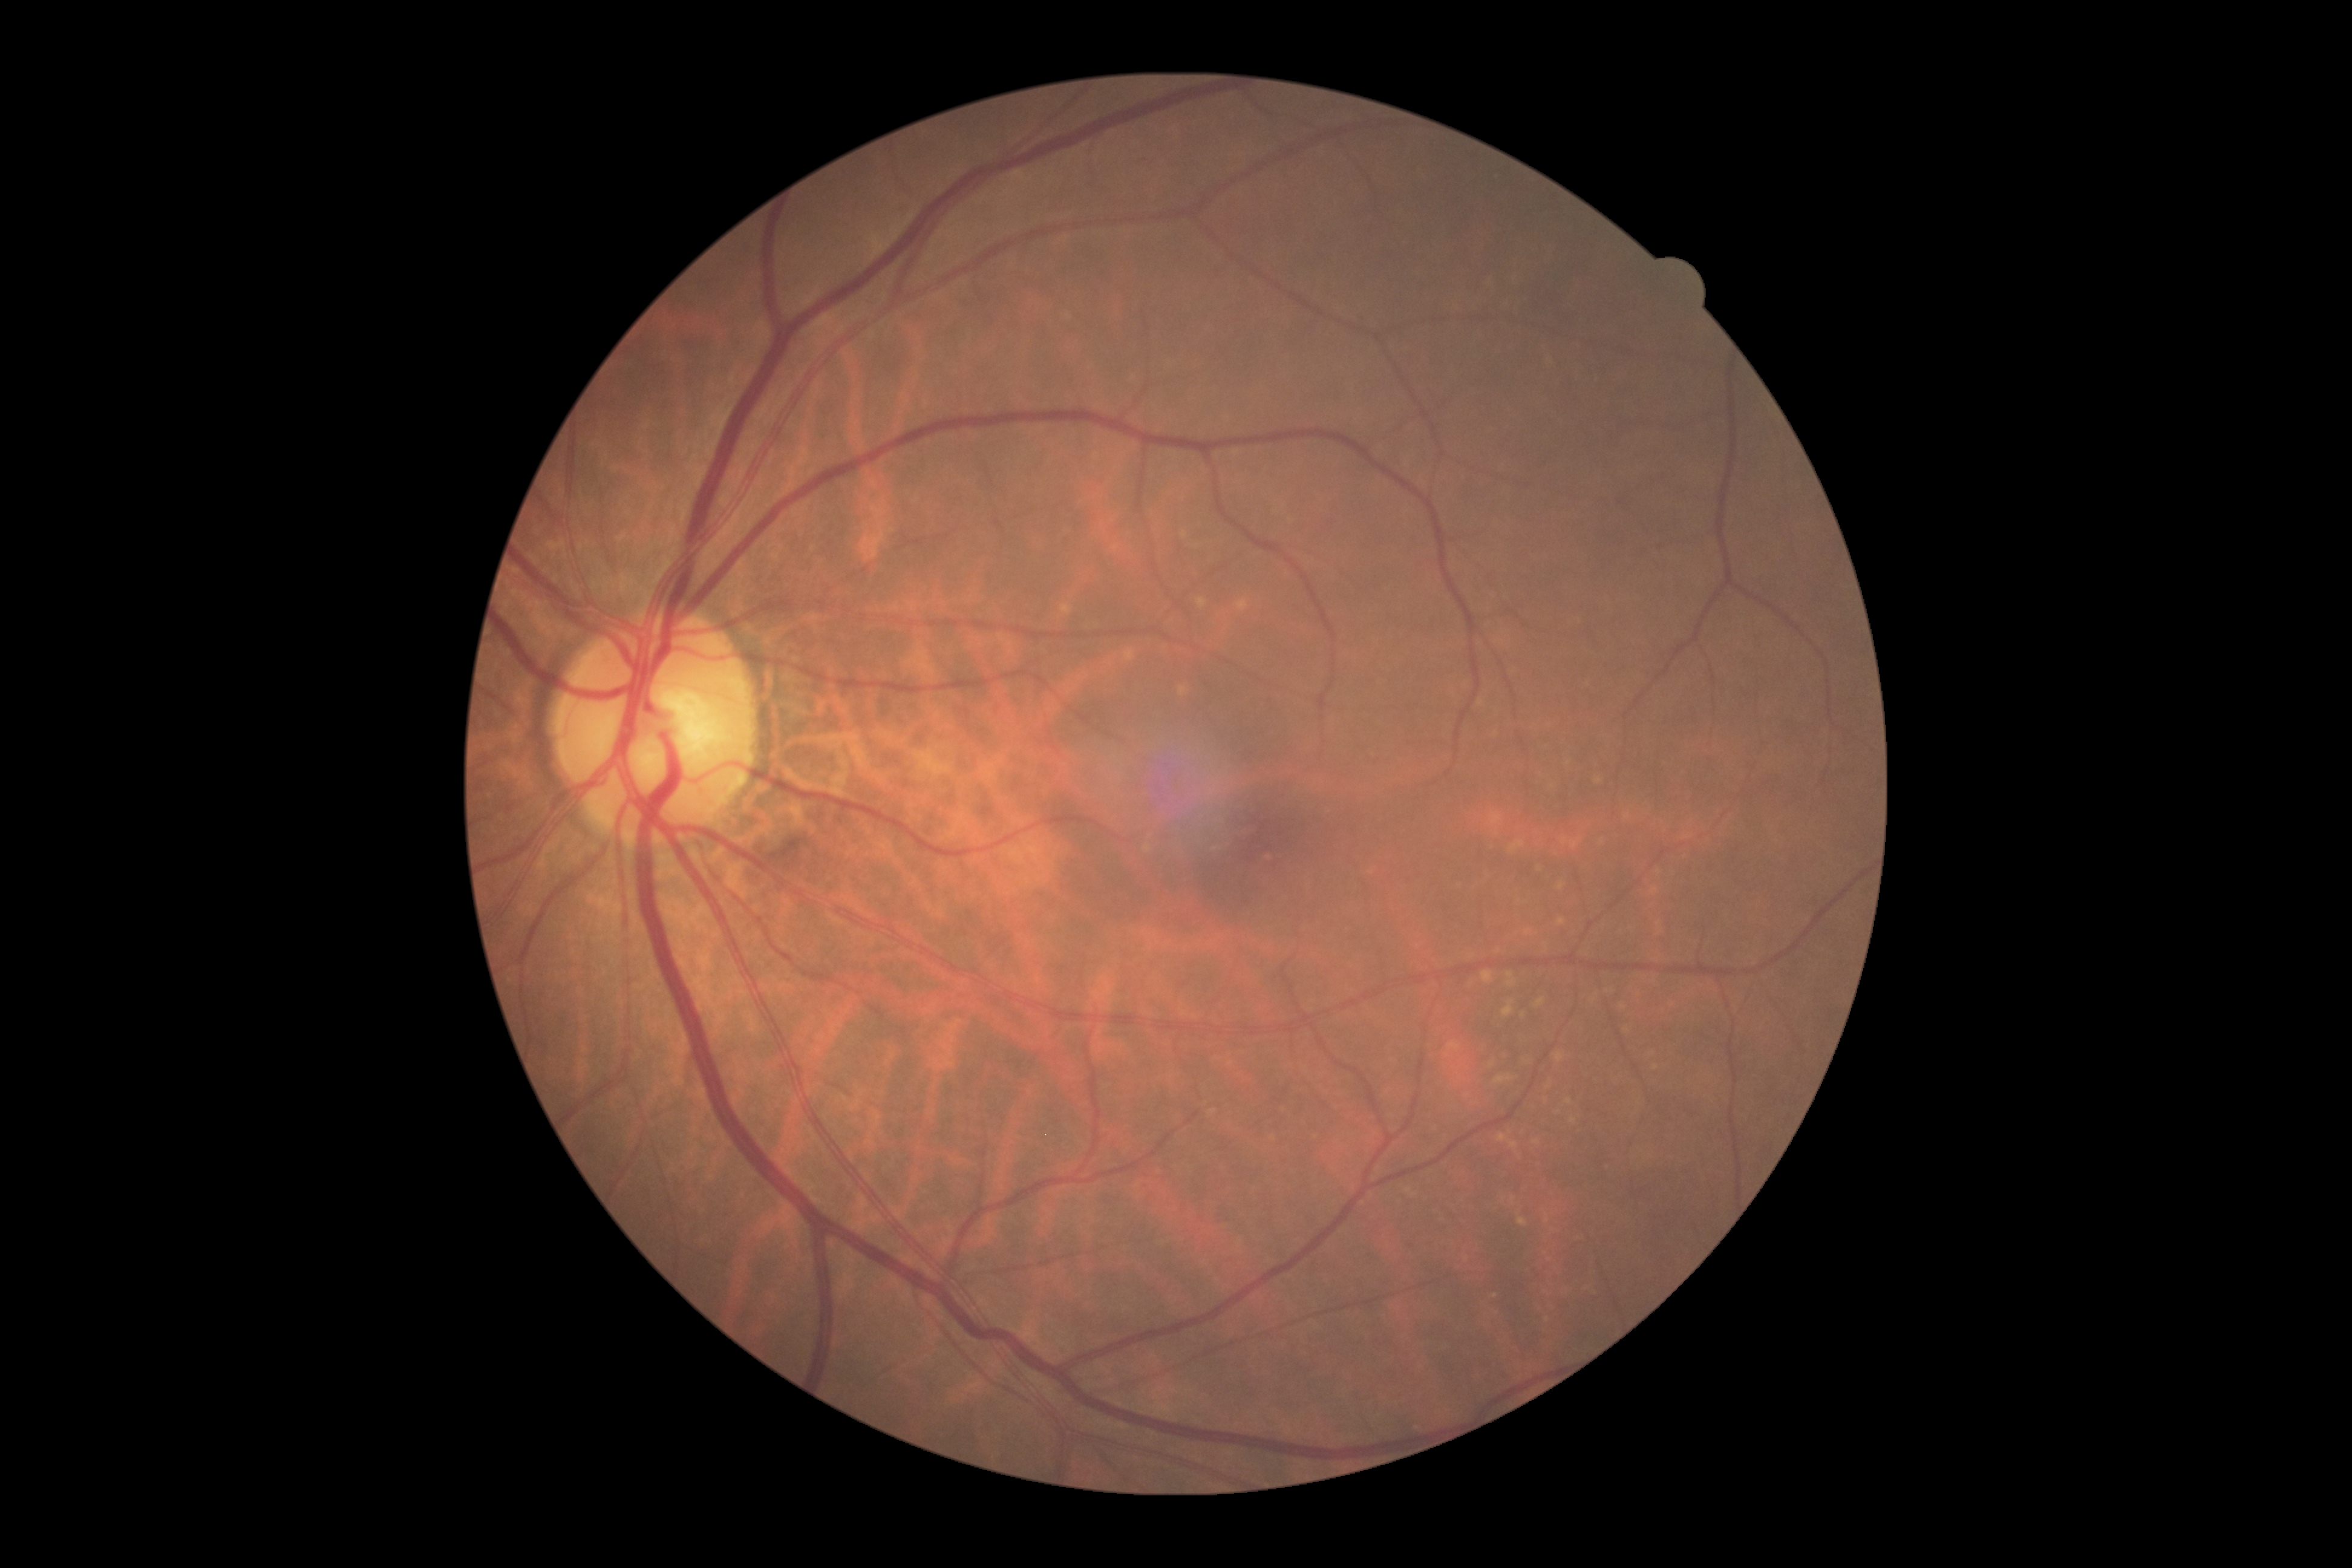

DR severity: no apparent retinopathy (grade 0).